Fundus photo, nonmydriatic fundus photograph:
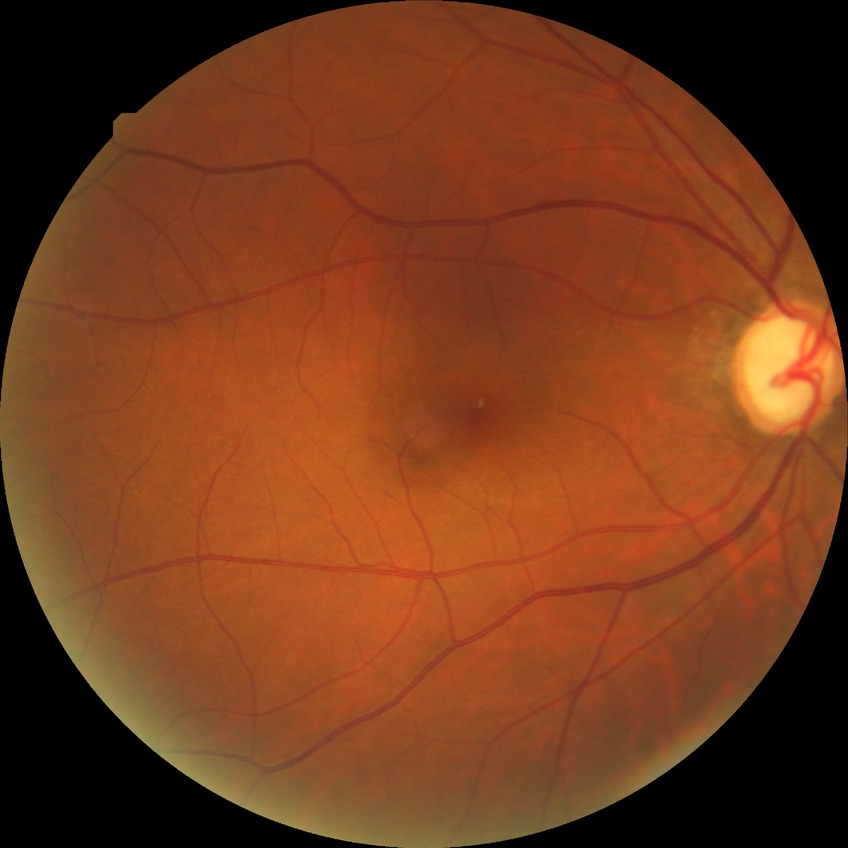

diabetic retinopathy (DR): NDR (no diabetic retinopathy).